1932 x 1910 pixels.
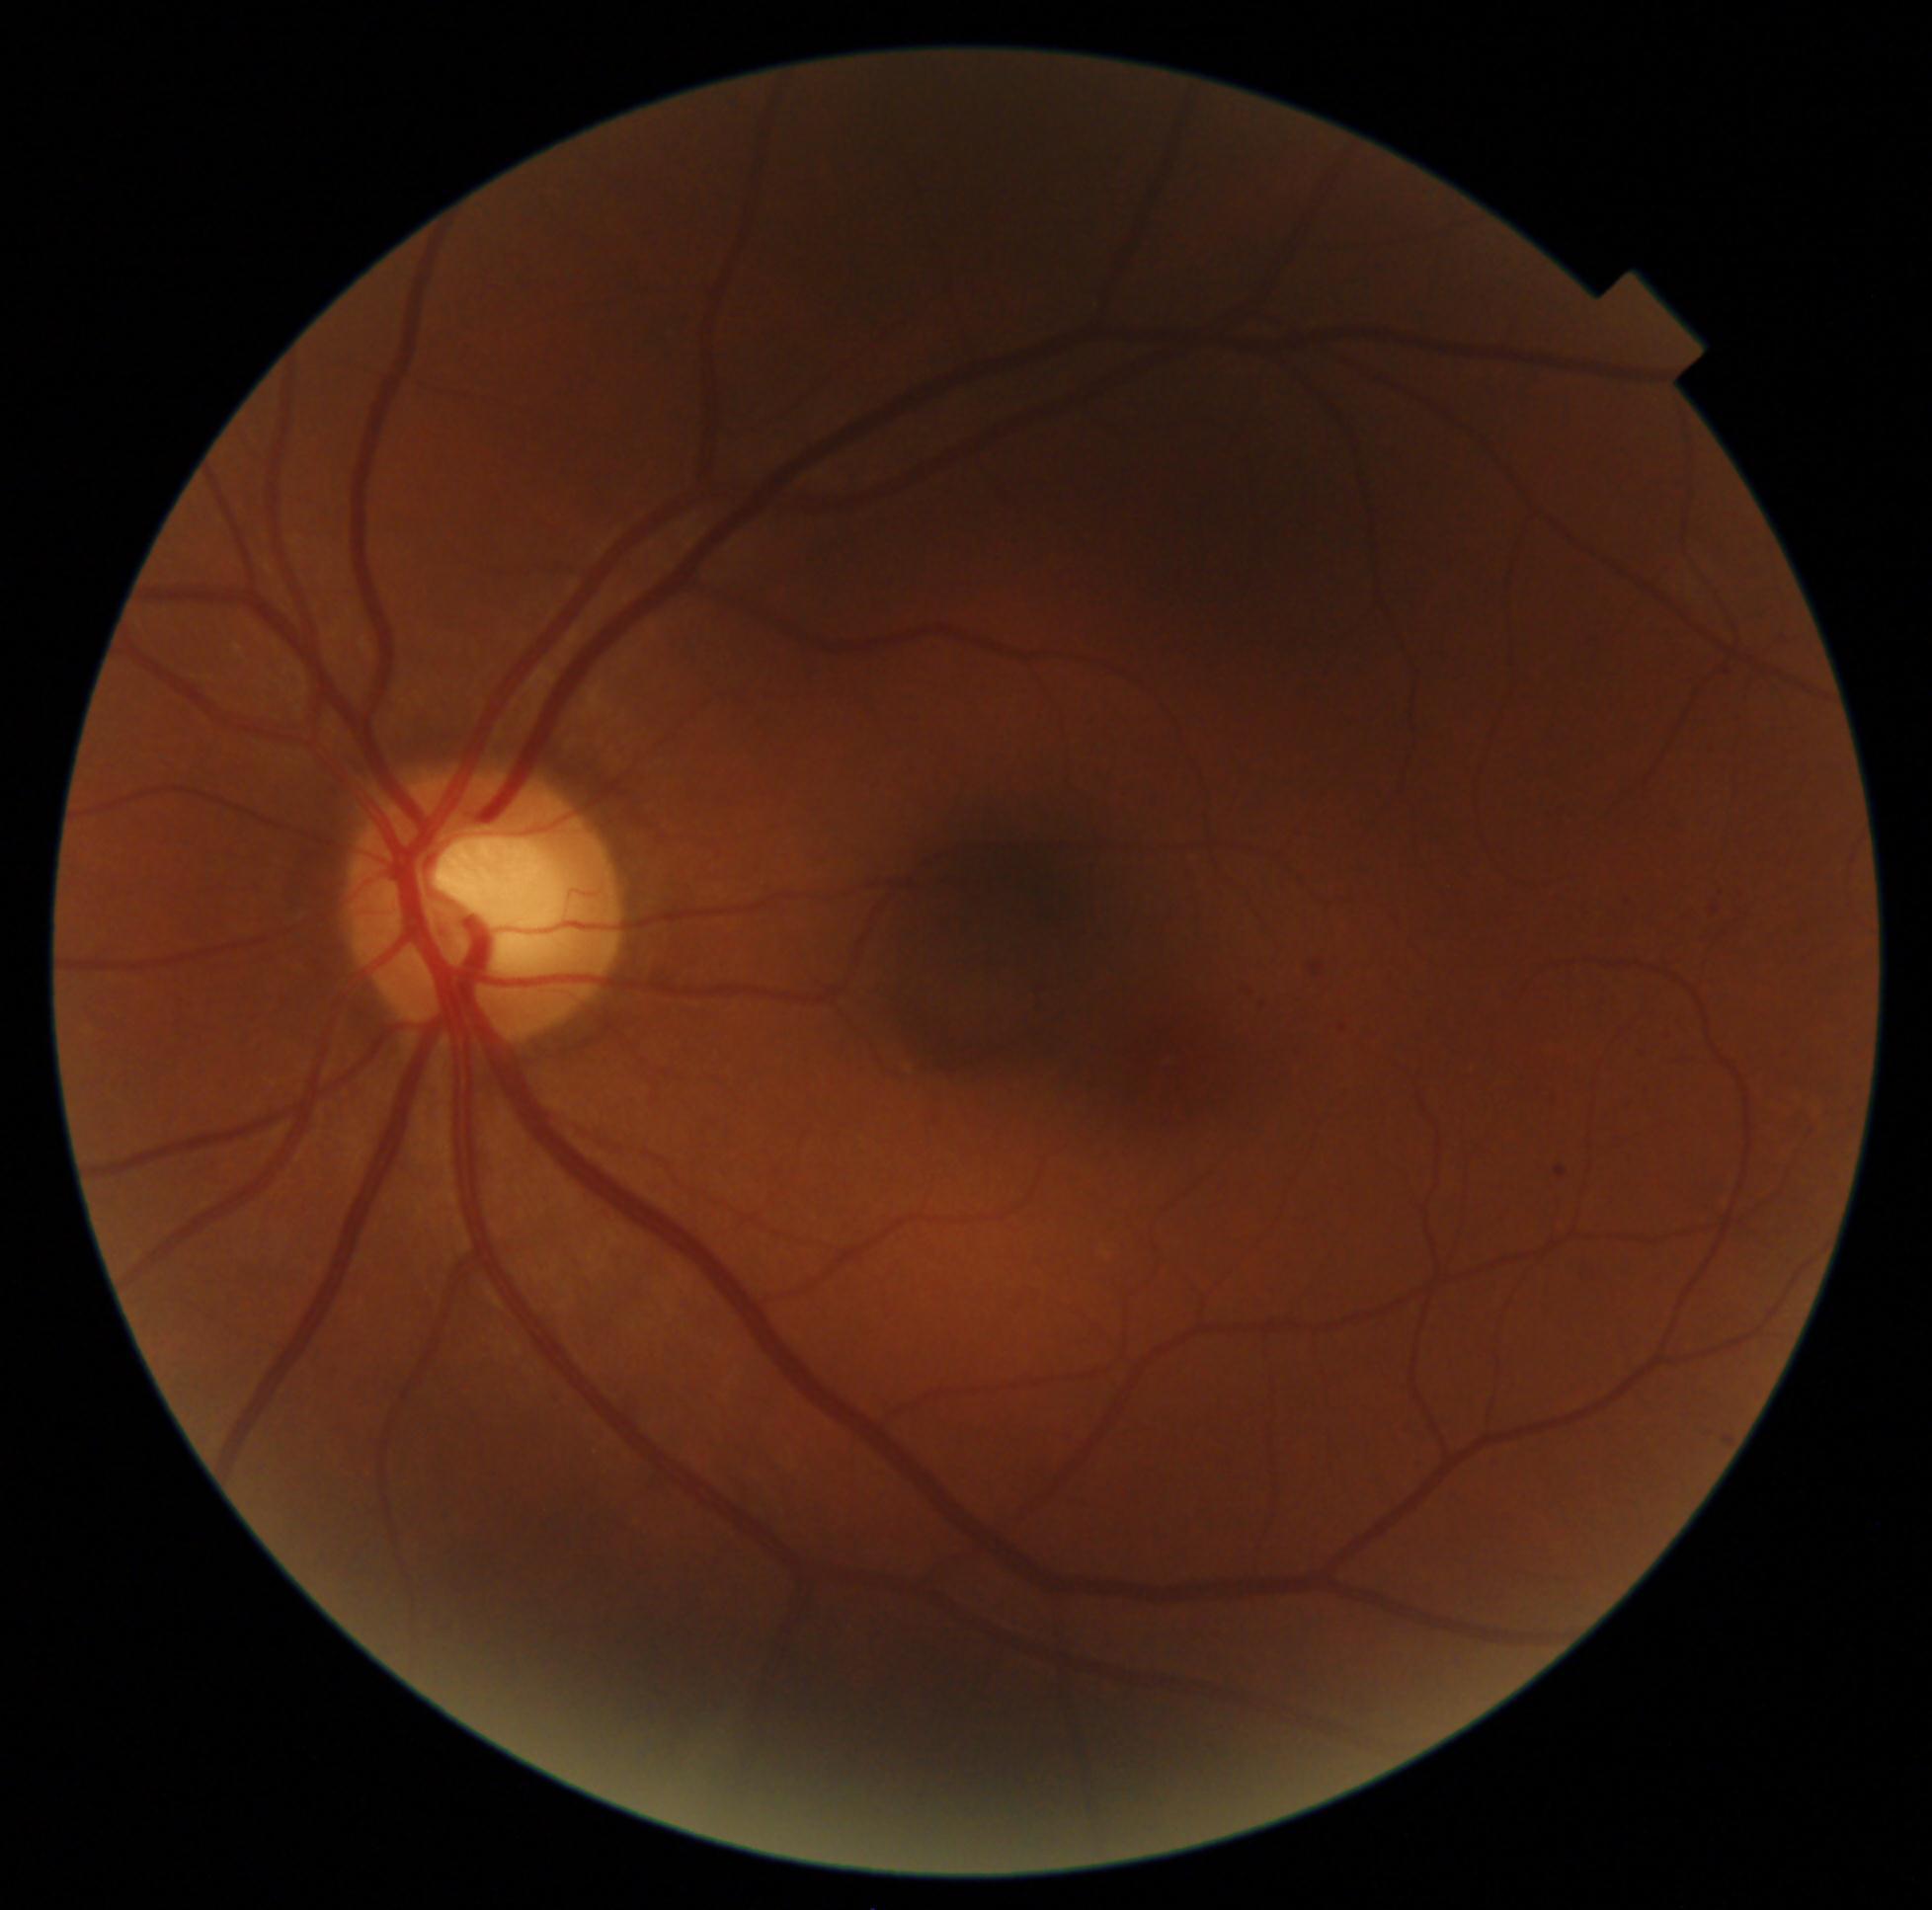

Findings:
• retinopathy — 1/4